Image size 2212x1659 · fundus photo · 45° FOV.
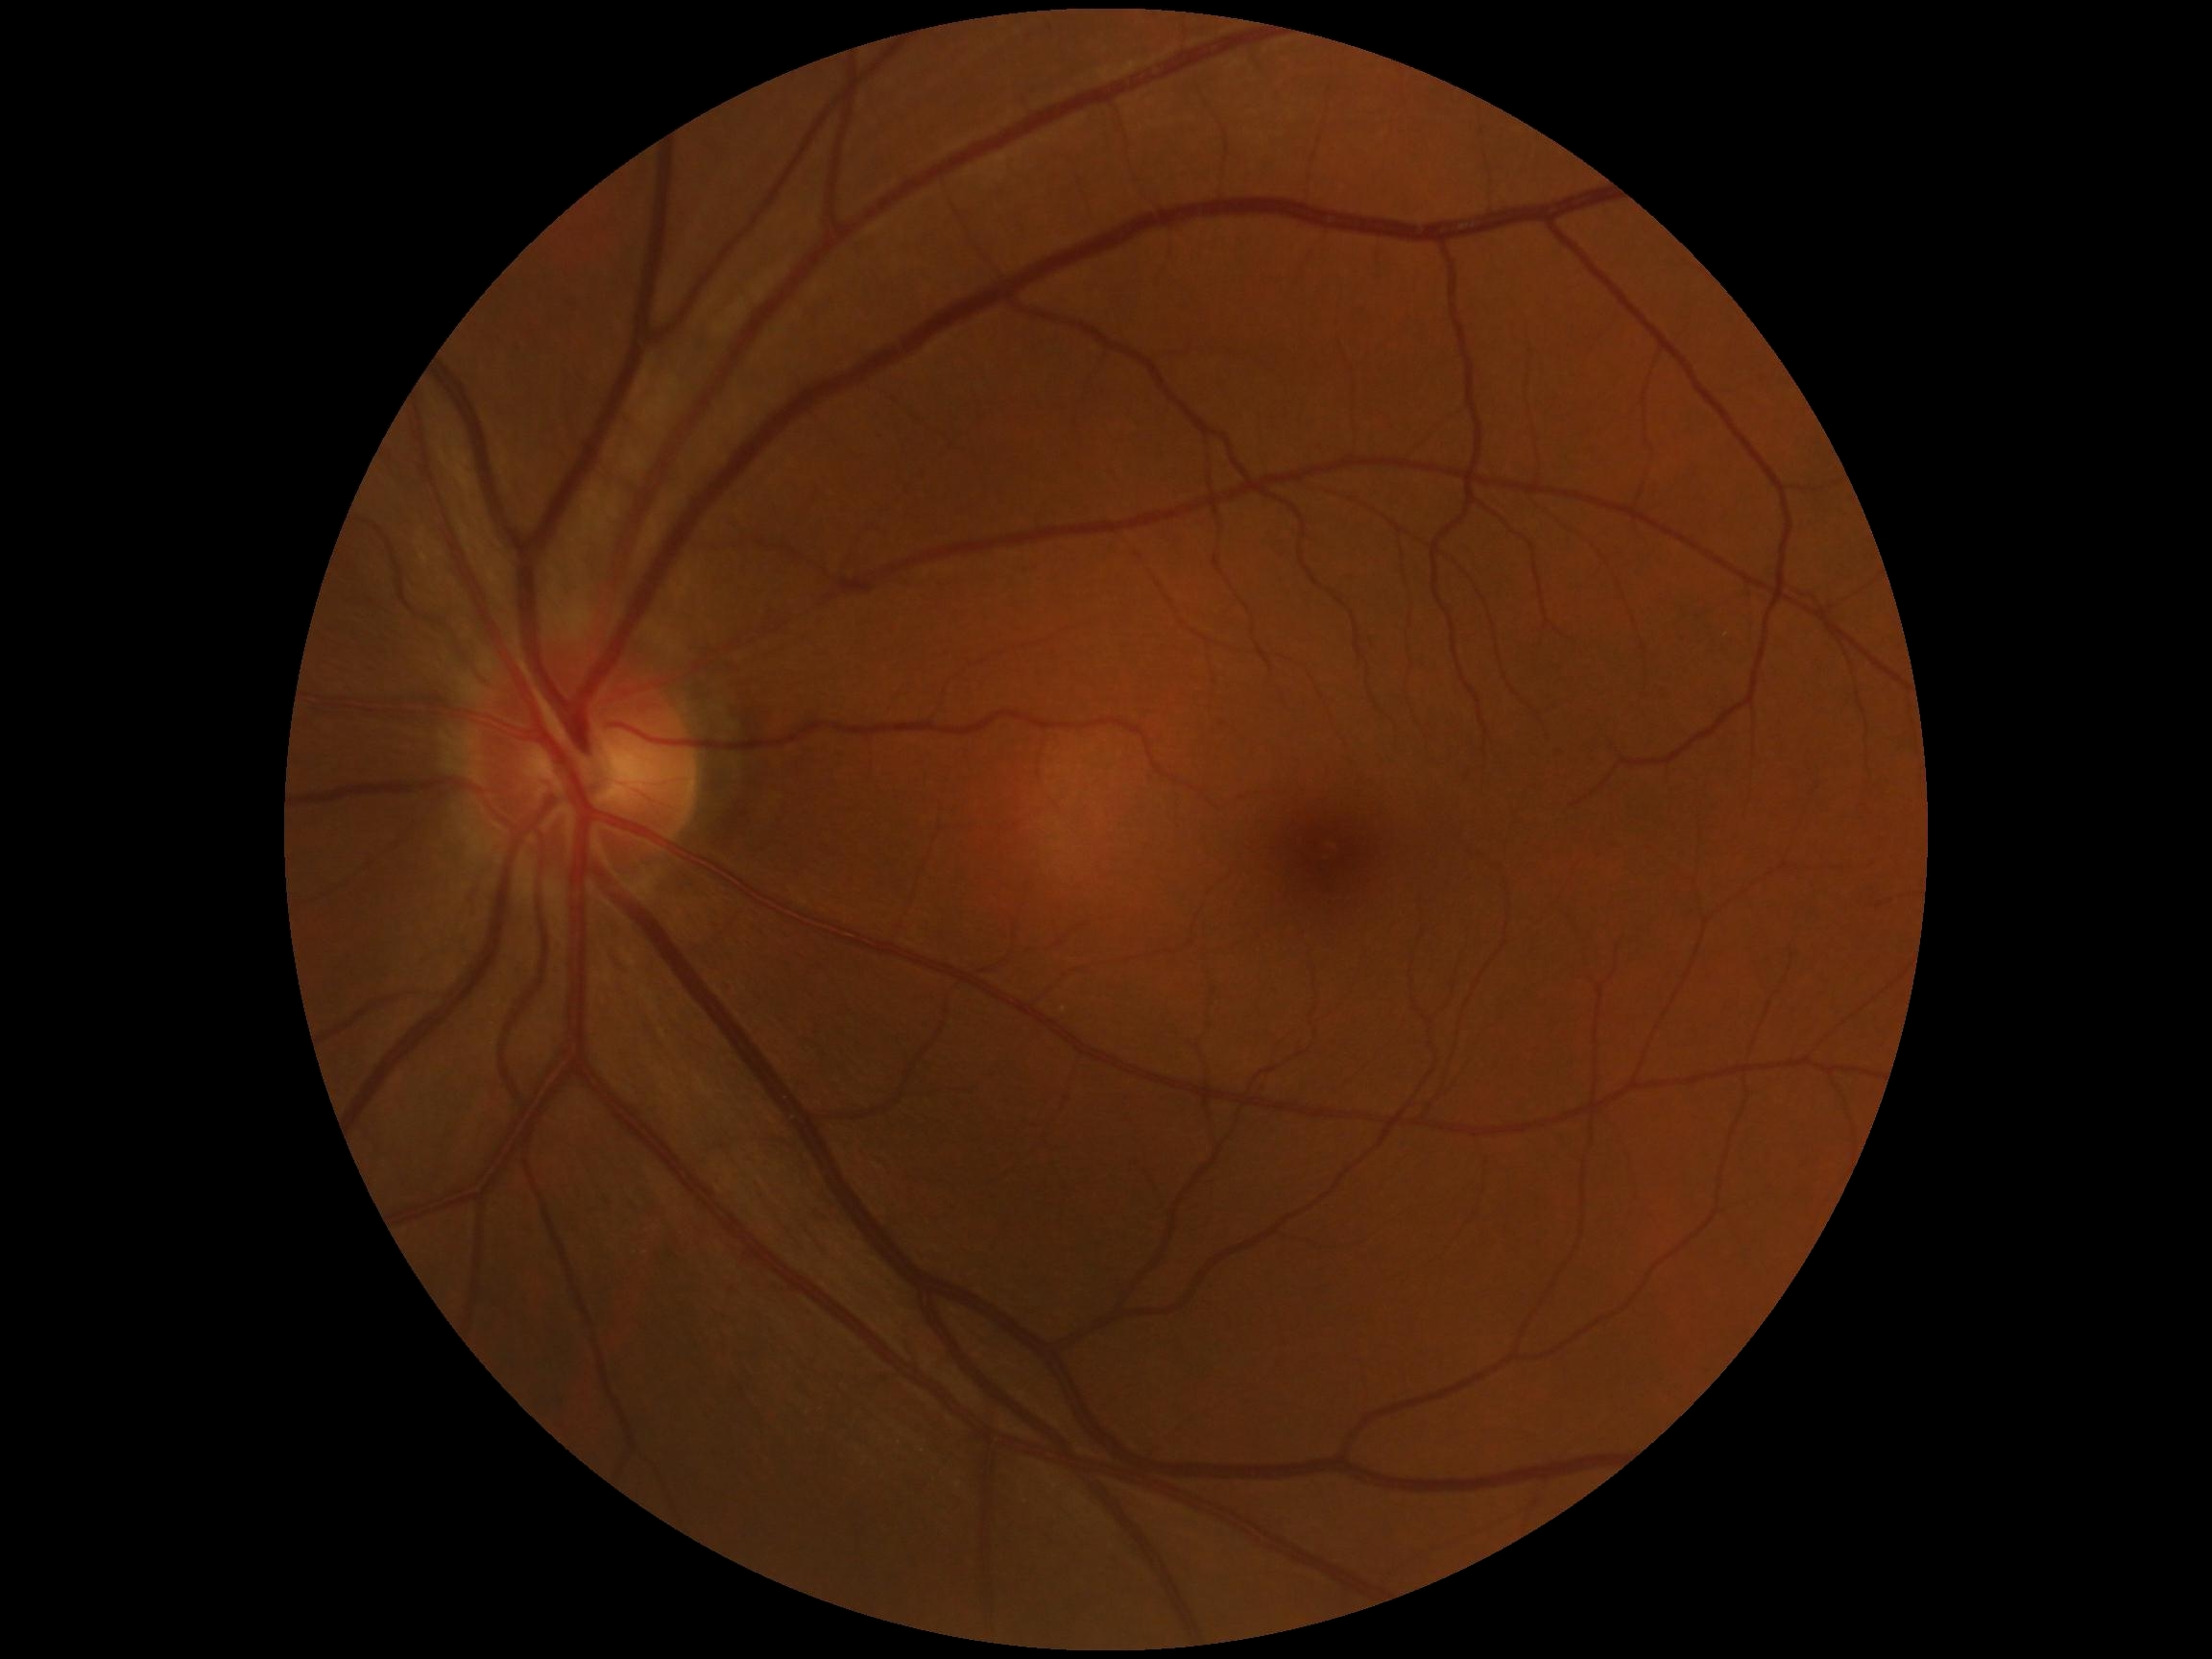
retinopathy=no apparent retinopathy (grade 0), DR impression=no apparent DR.